Retinal fundus photograph · 2346x1568 — 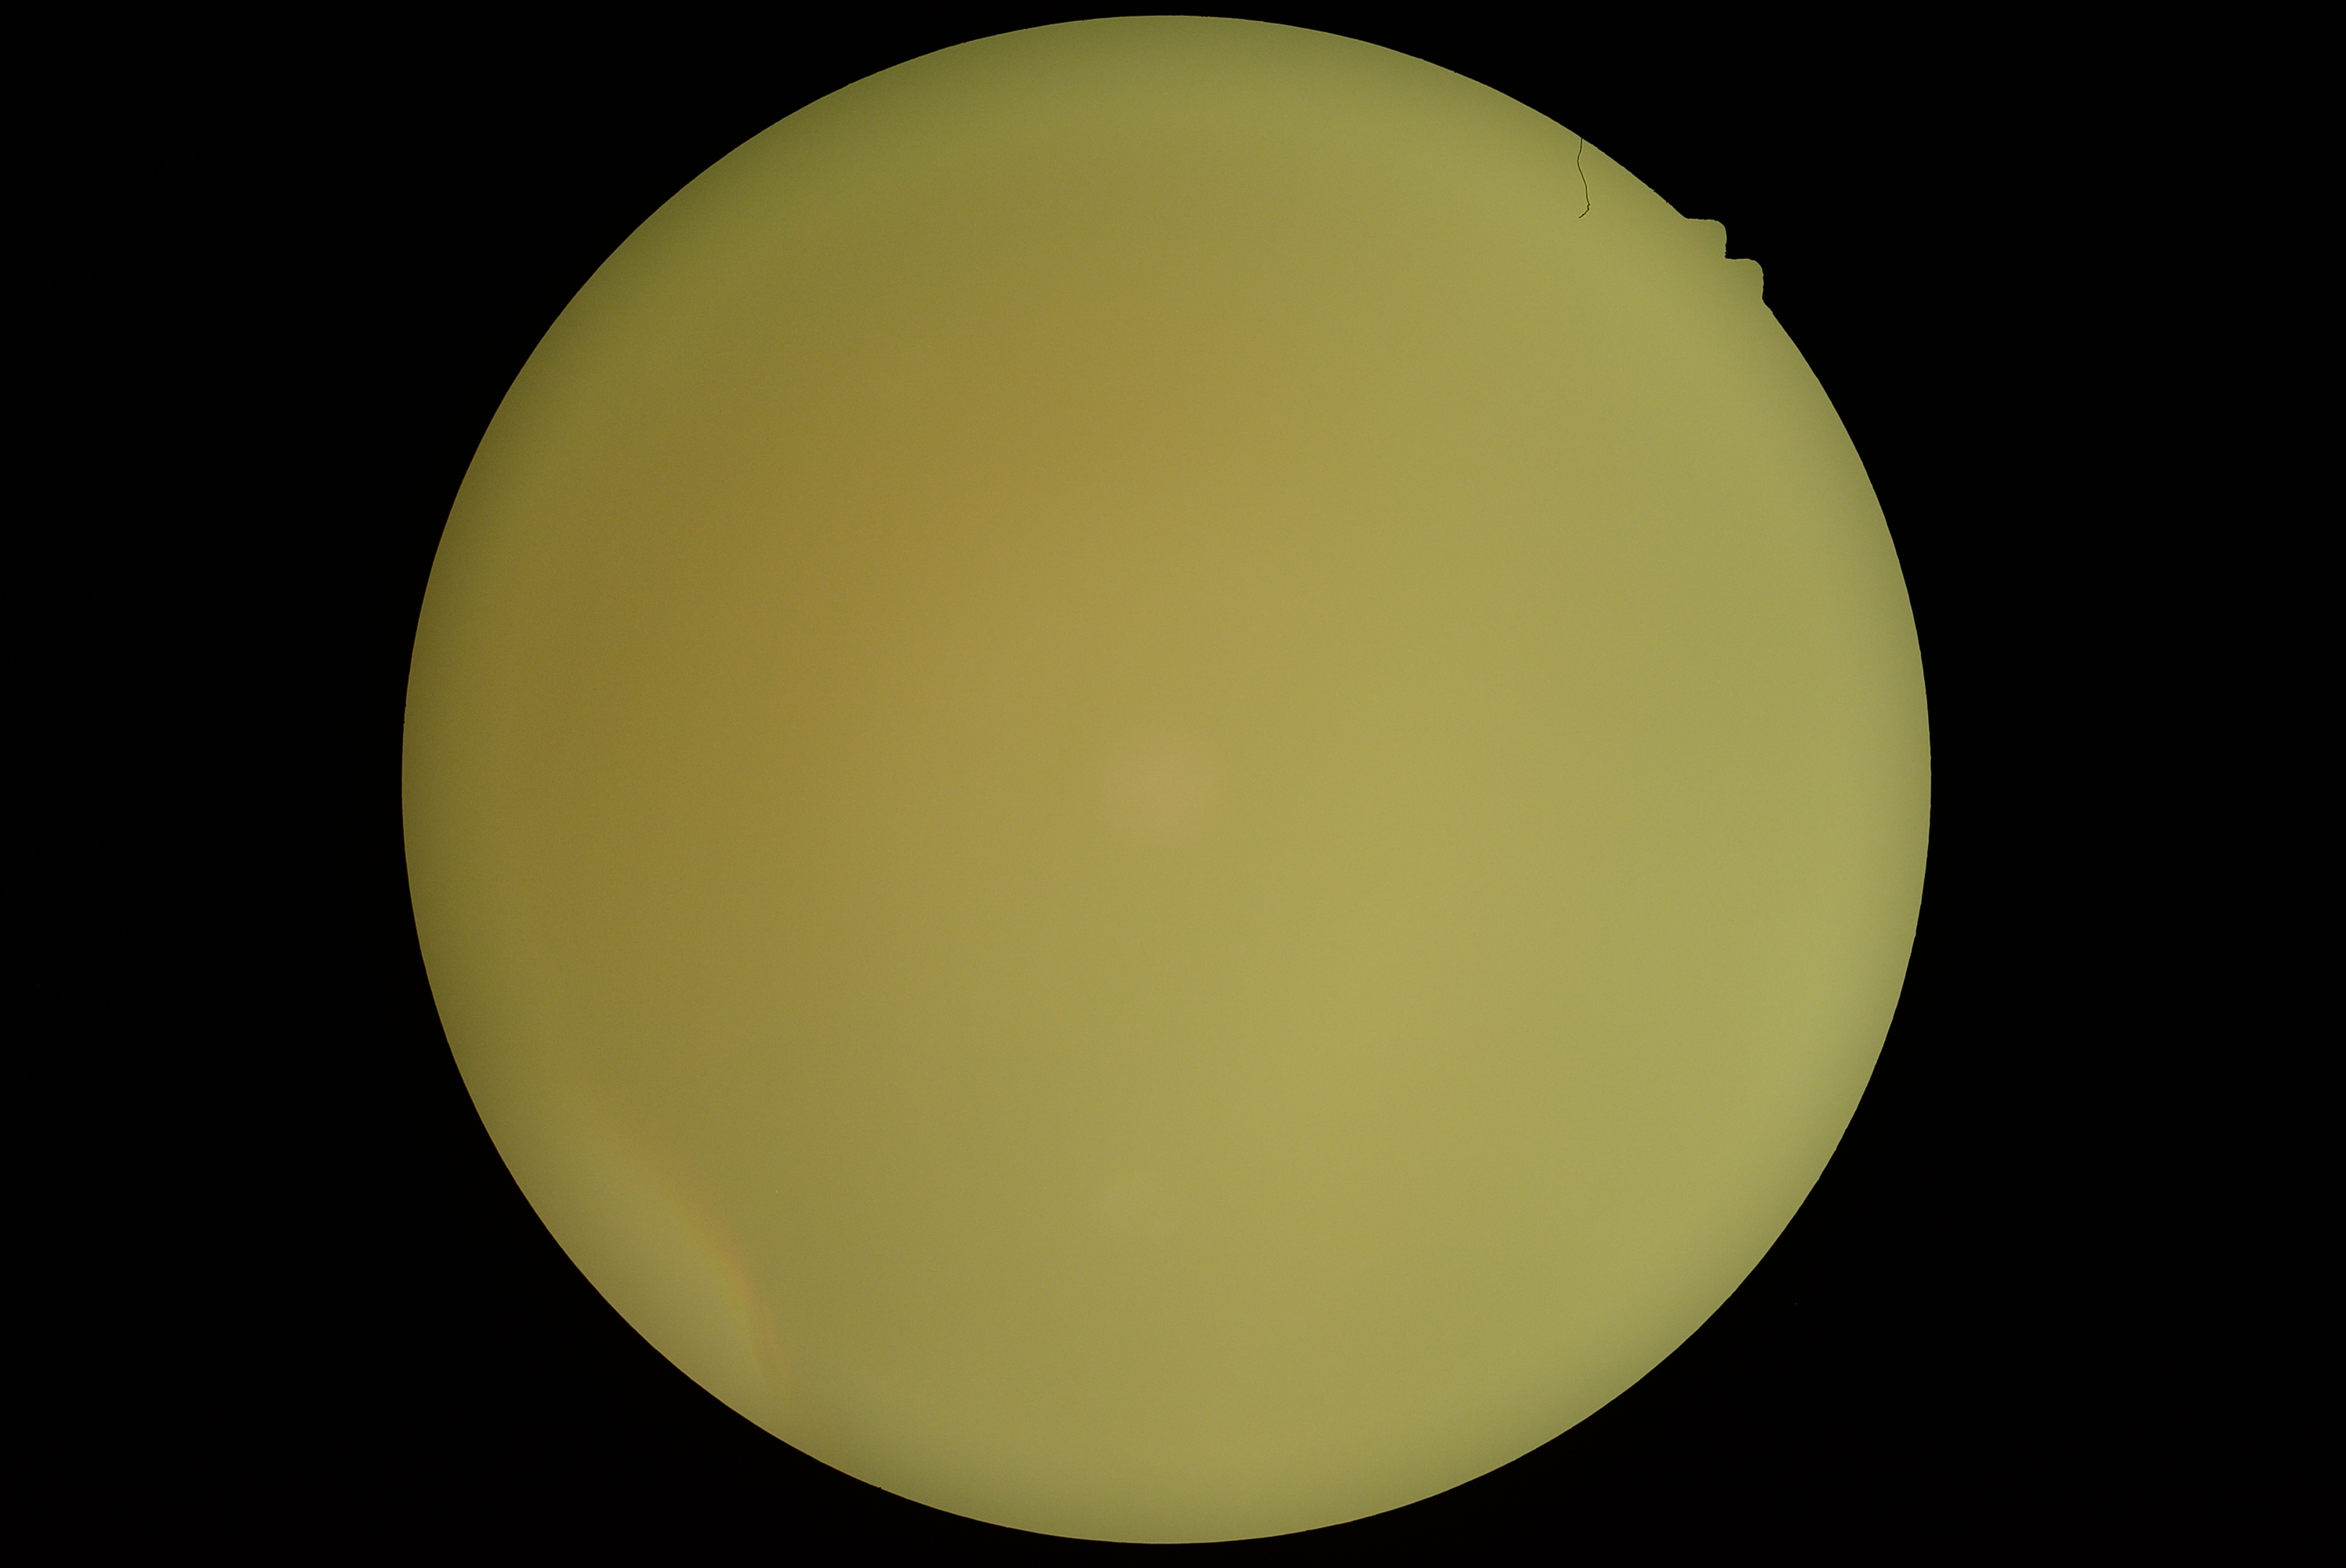

Diabetic retinopathy (DR): ungradable due to poor image quality.
Image quality is insufficient for diabetic retinopathy assessment.